FOV: 45 degrees
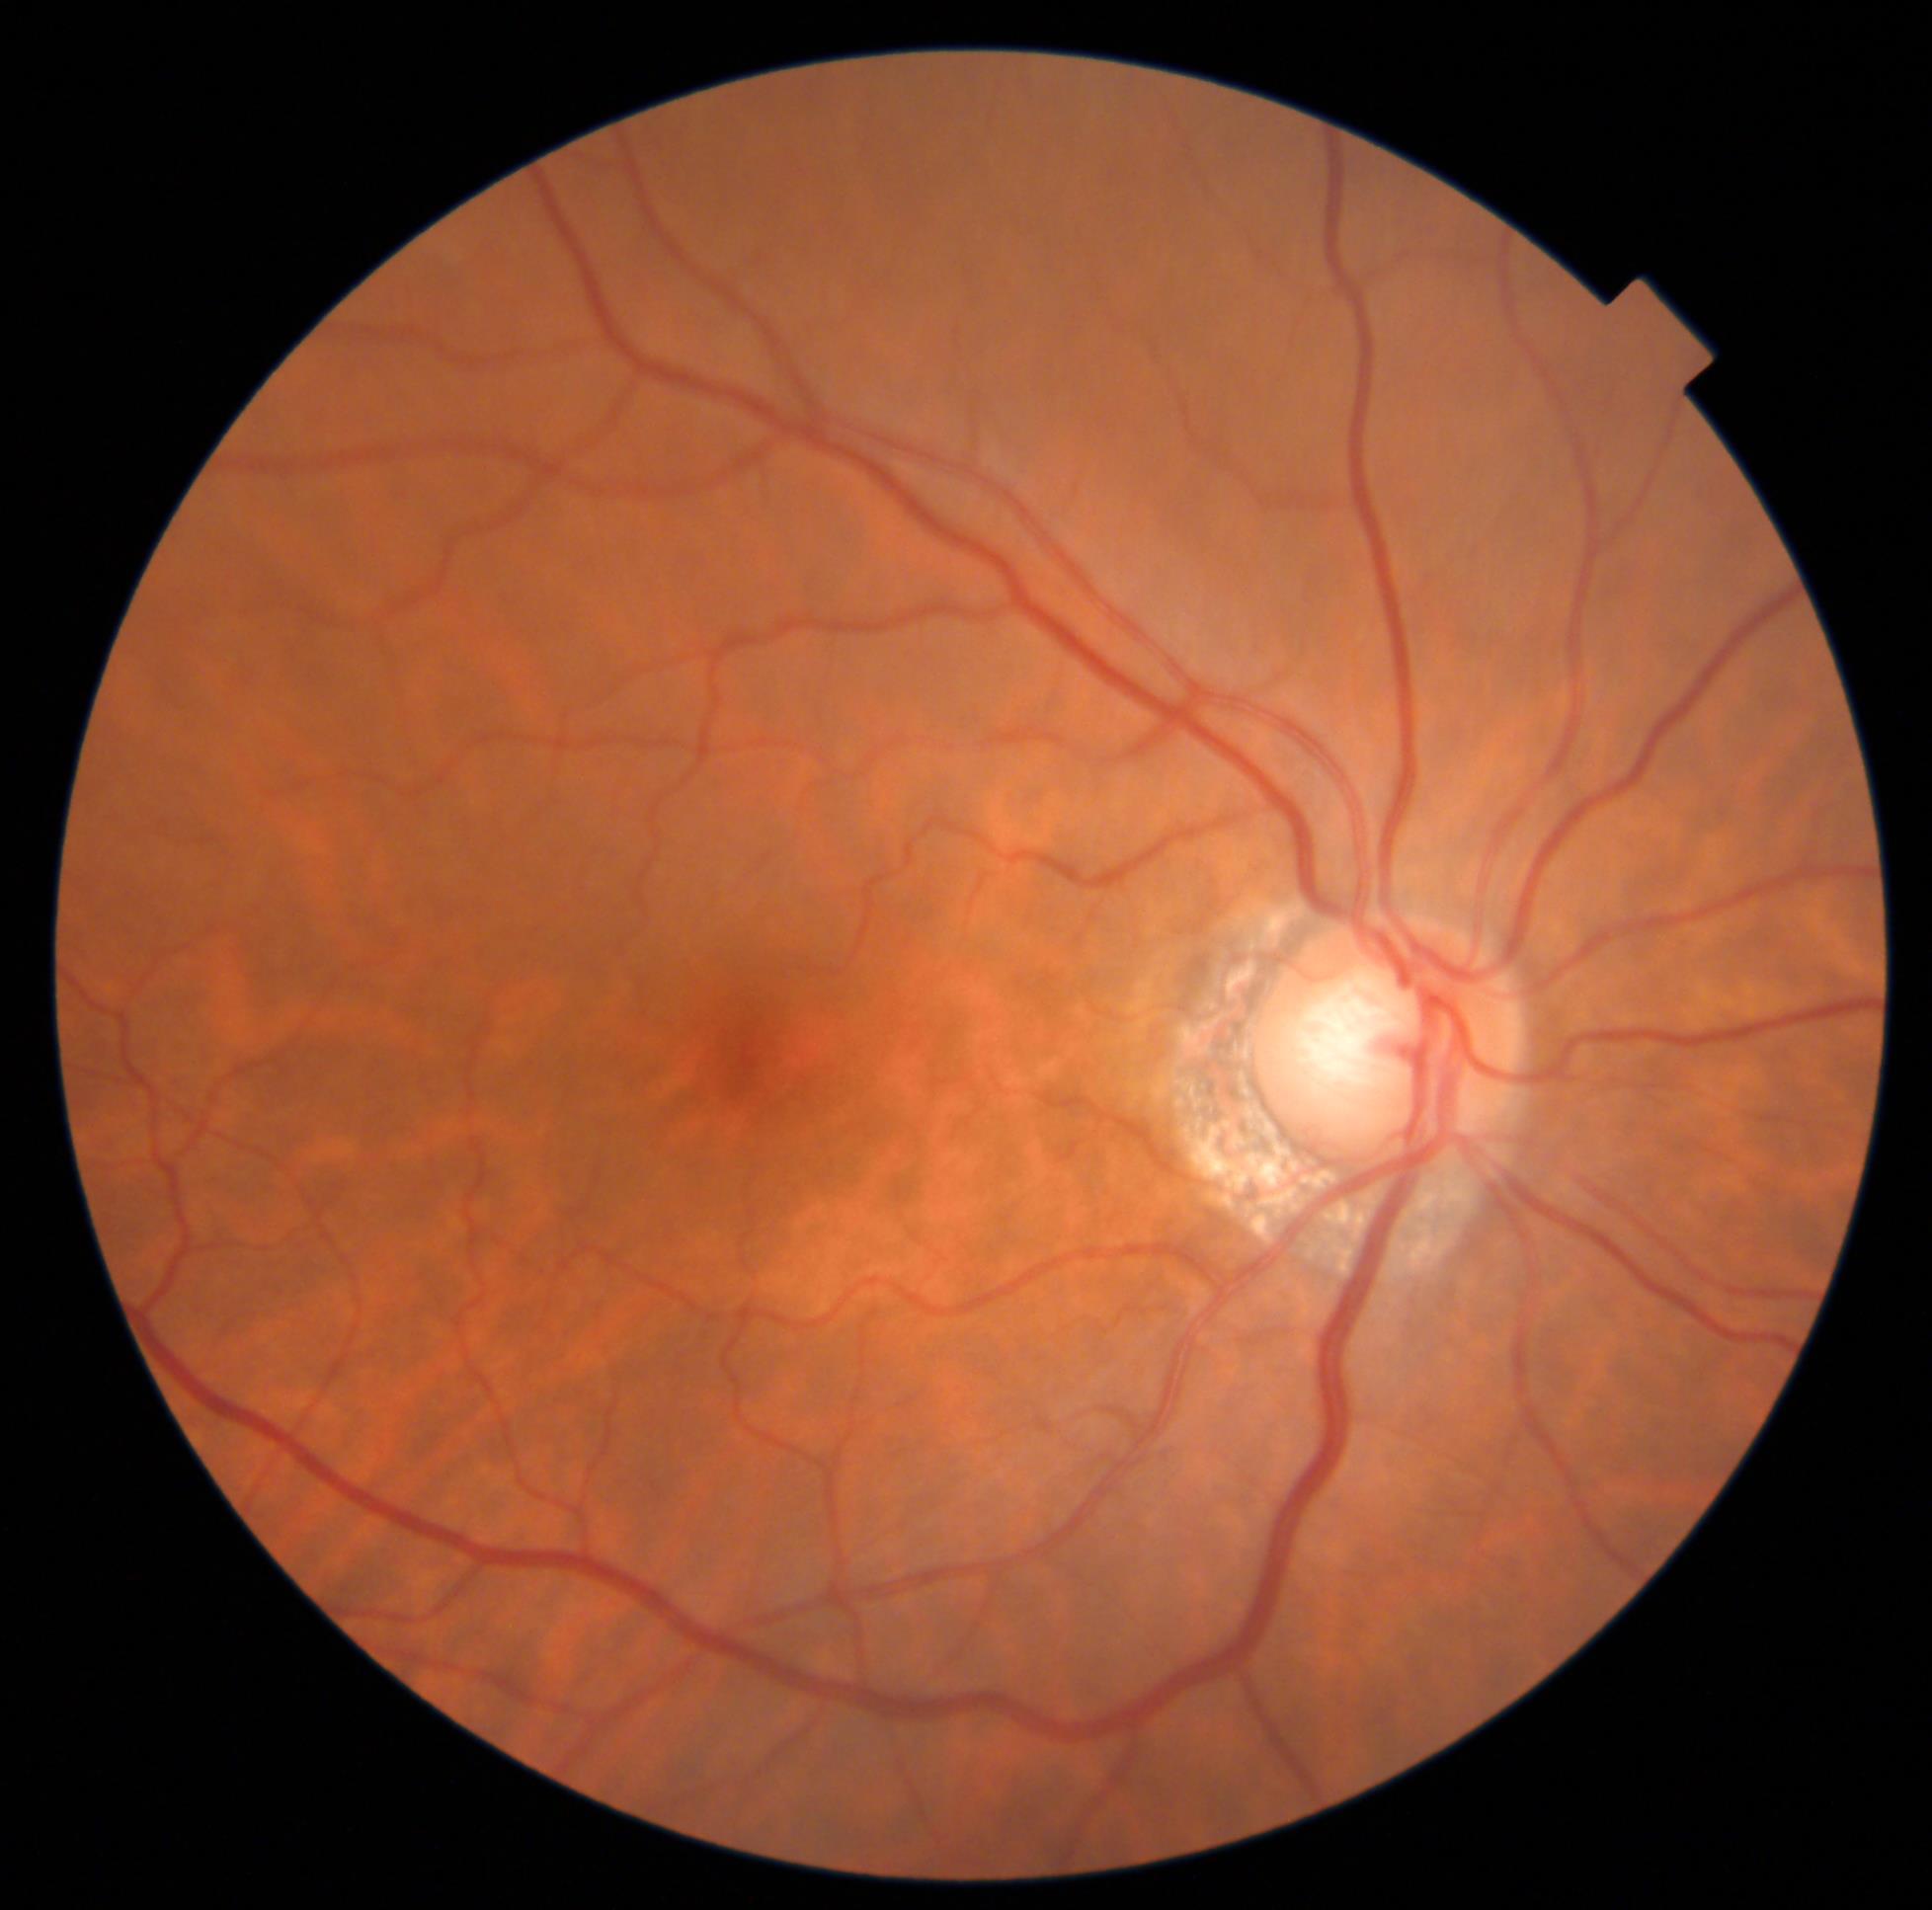

{
  "dr_grade": "grade 0 (no apparent retinopathy)",
  "dr_impression": "negative for DR"
}